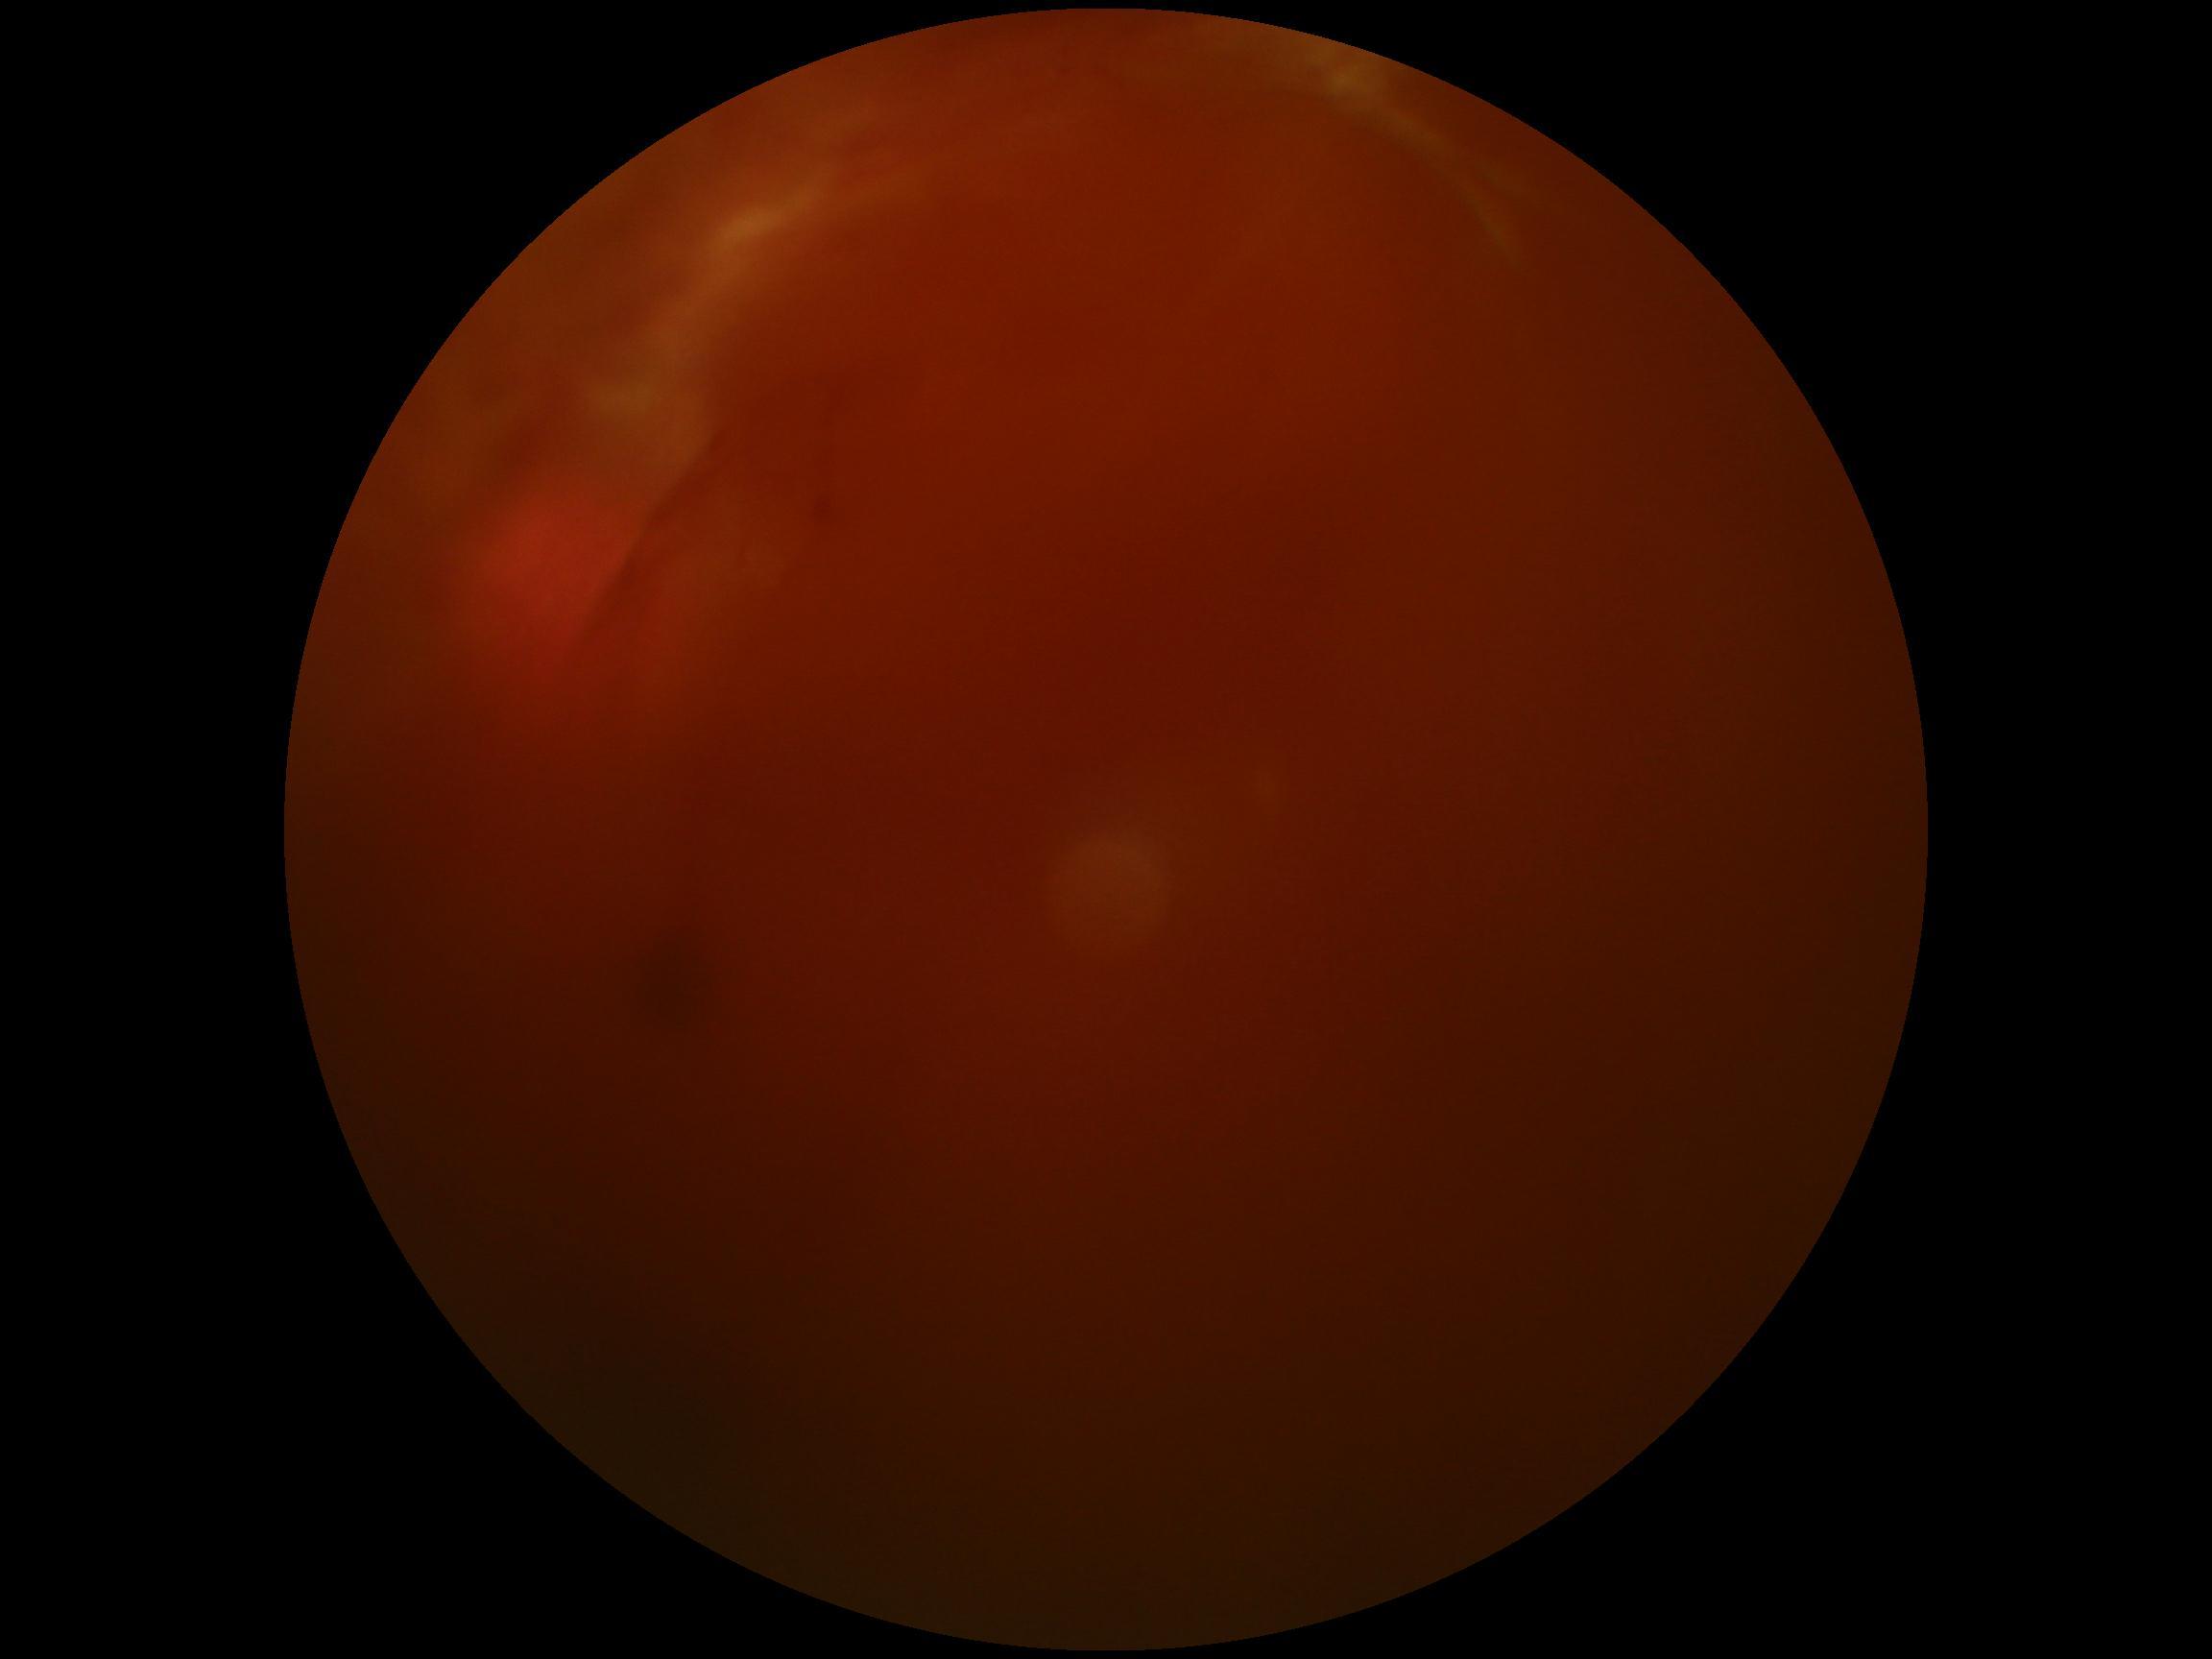 Diabetic retinopathy (DR) is 4. The retinopathy is classified as proliferative diabetic retinopathy.